1920 x 1088 pixels — 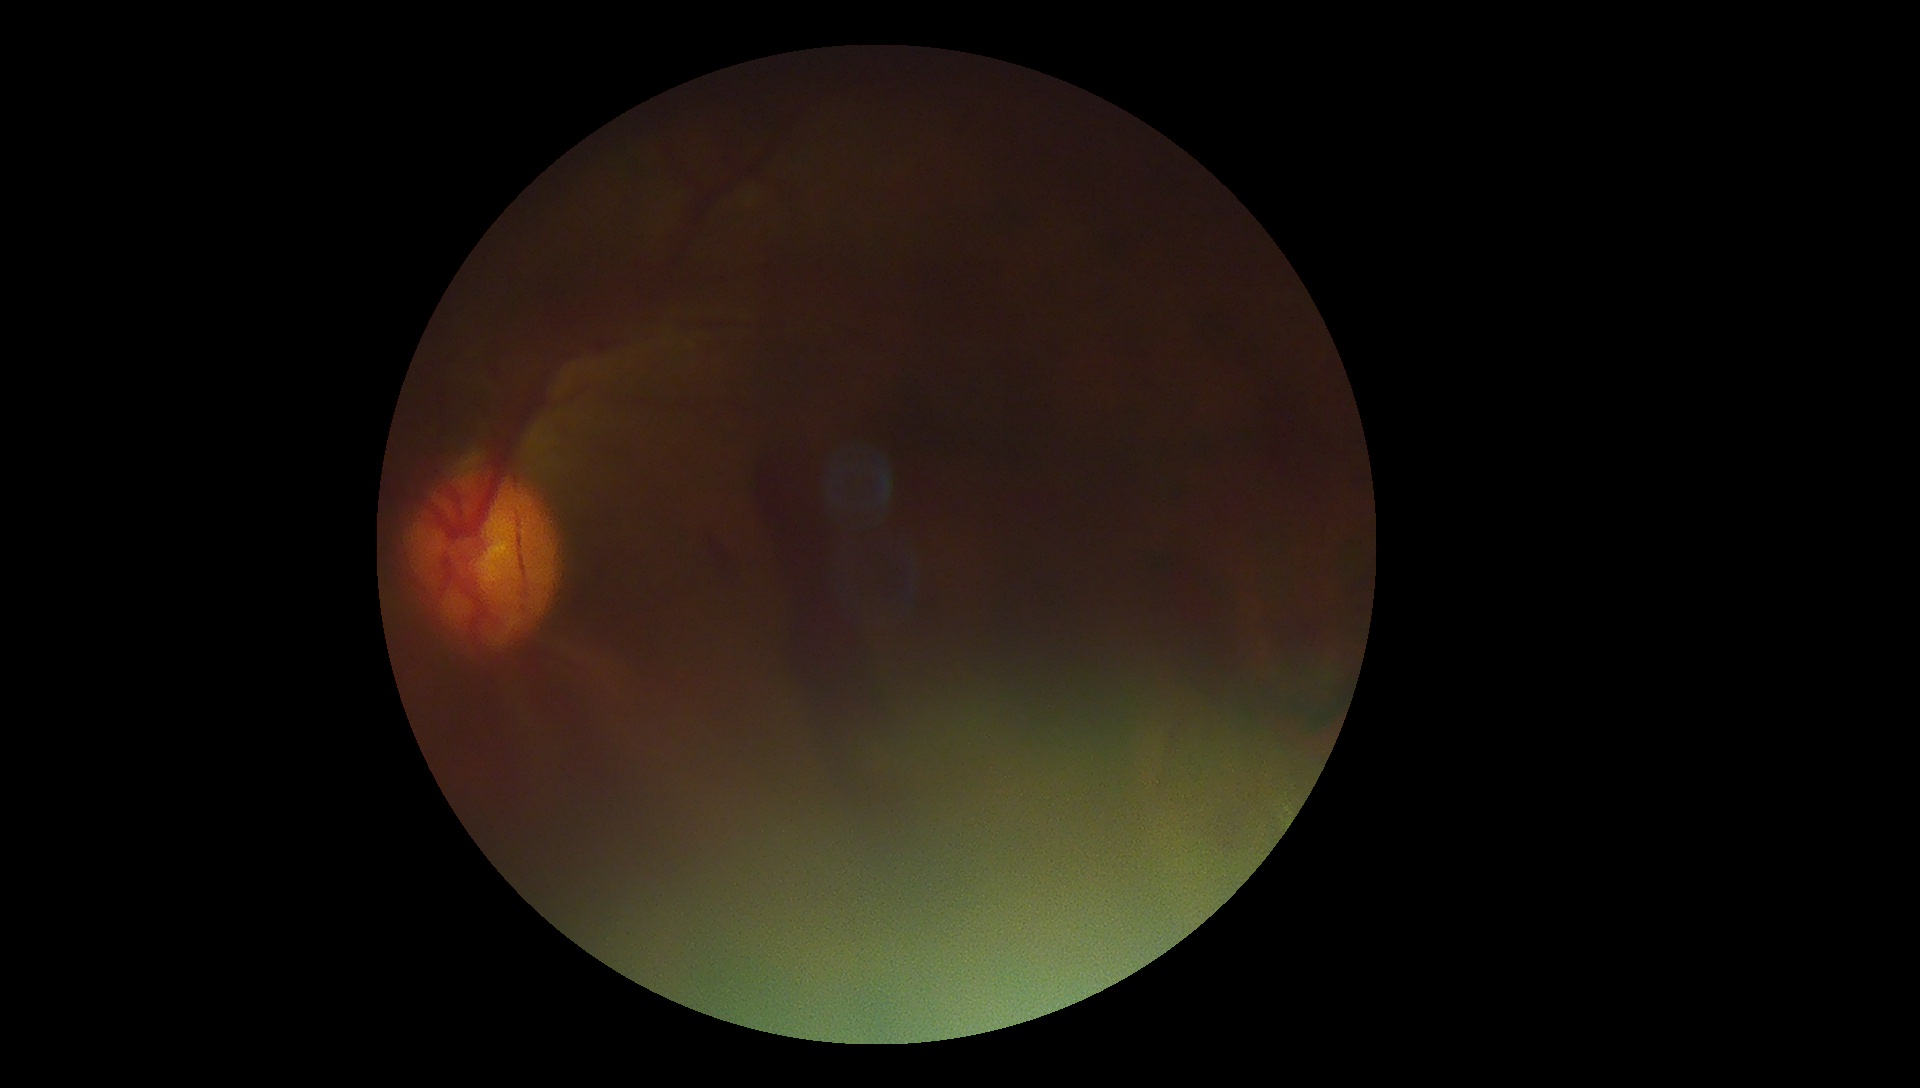 retinopathy grade@4/4 — neovascularization and/or vitreous/pre-retinal hemorrhage.